Phoenix ICON wide-field infant fundus image · 1240 x 1240 pixels
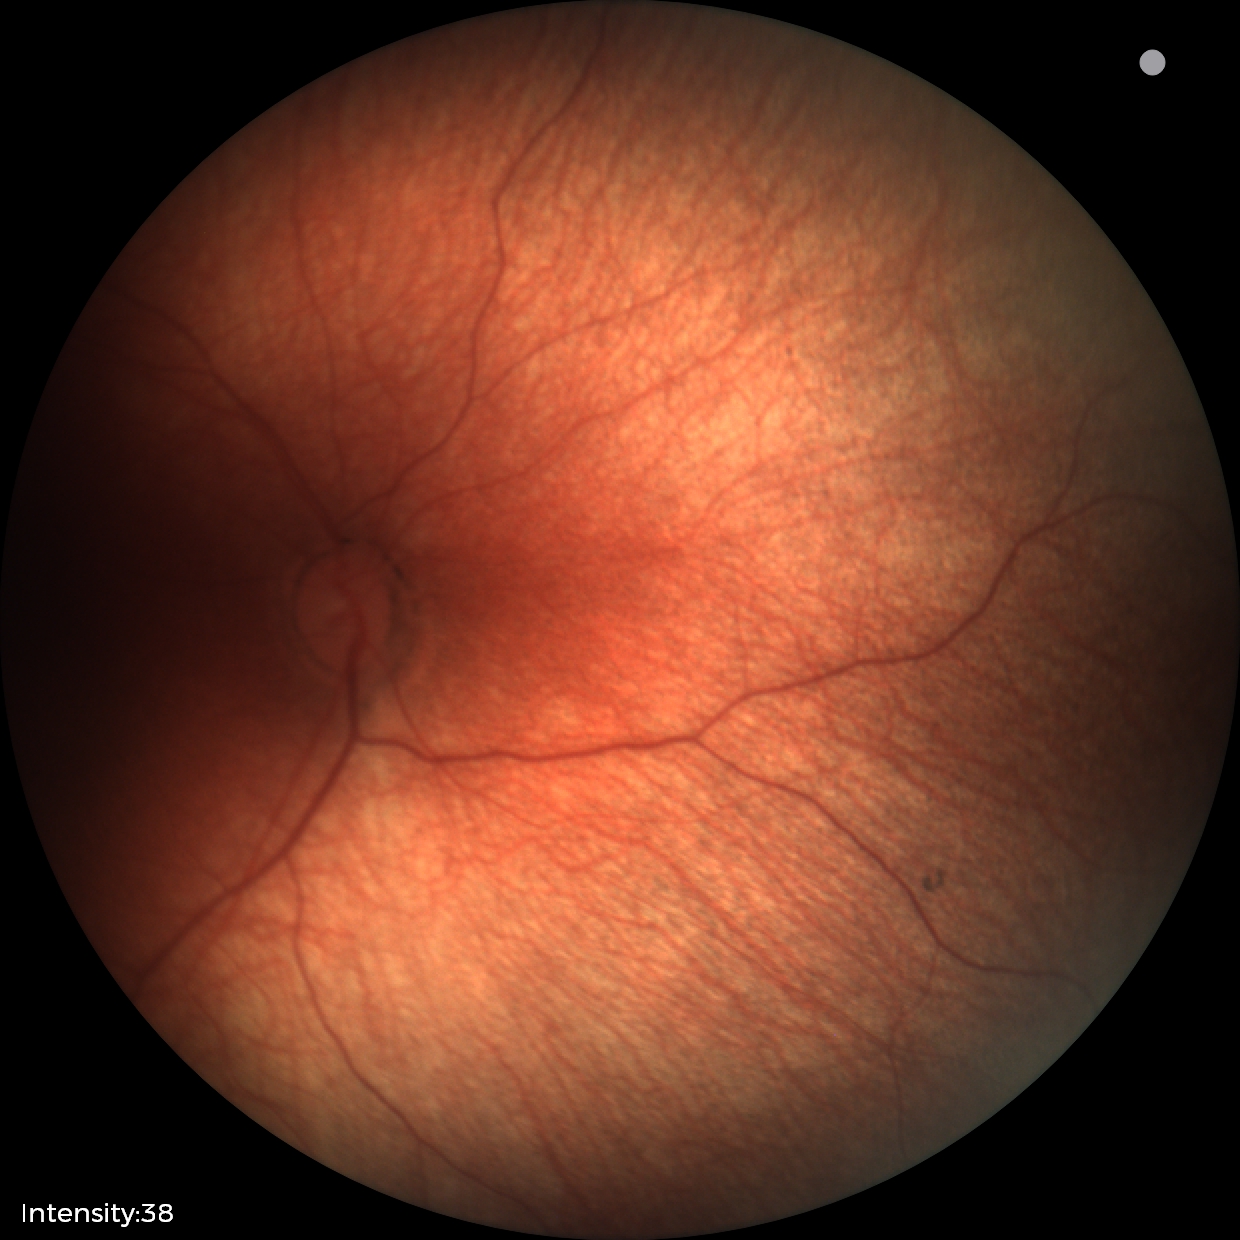 Normal screening examination.